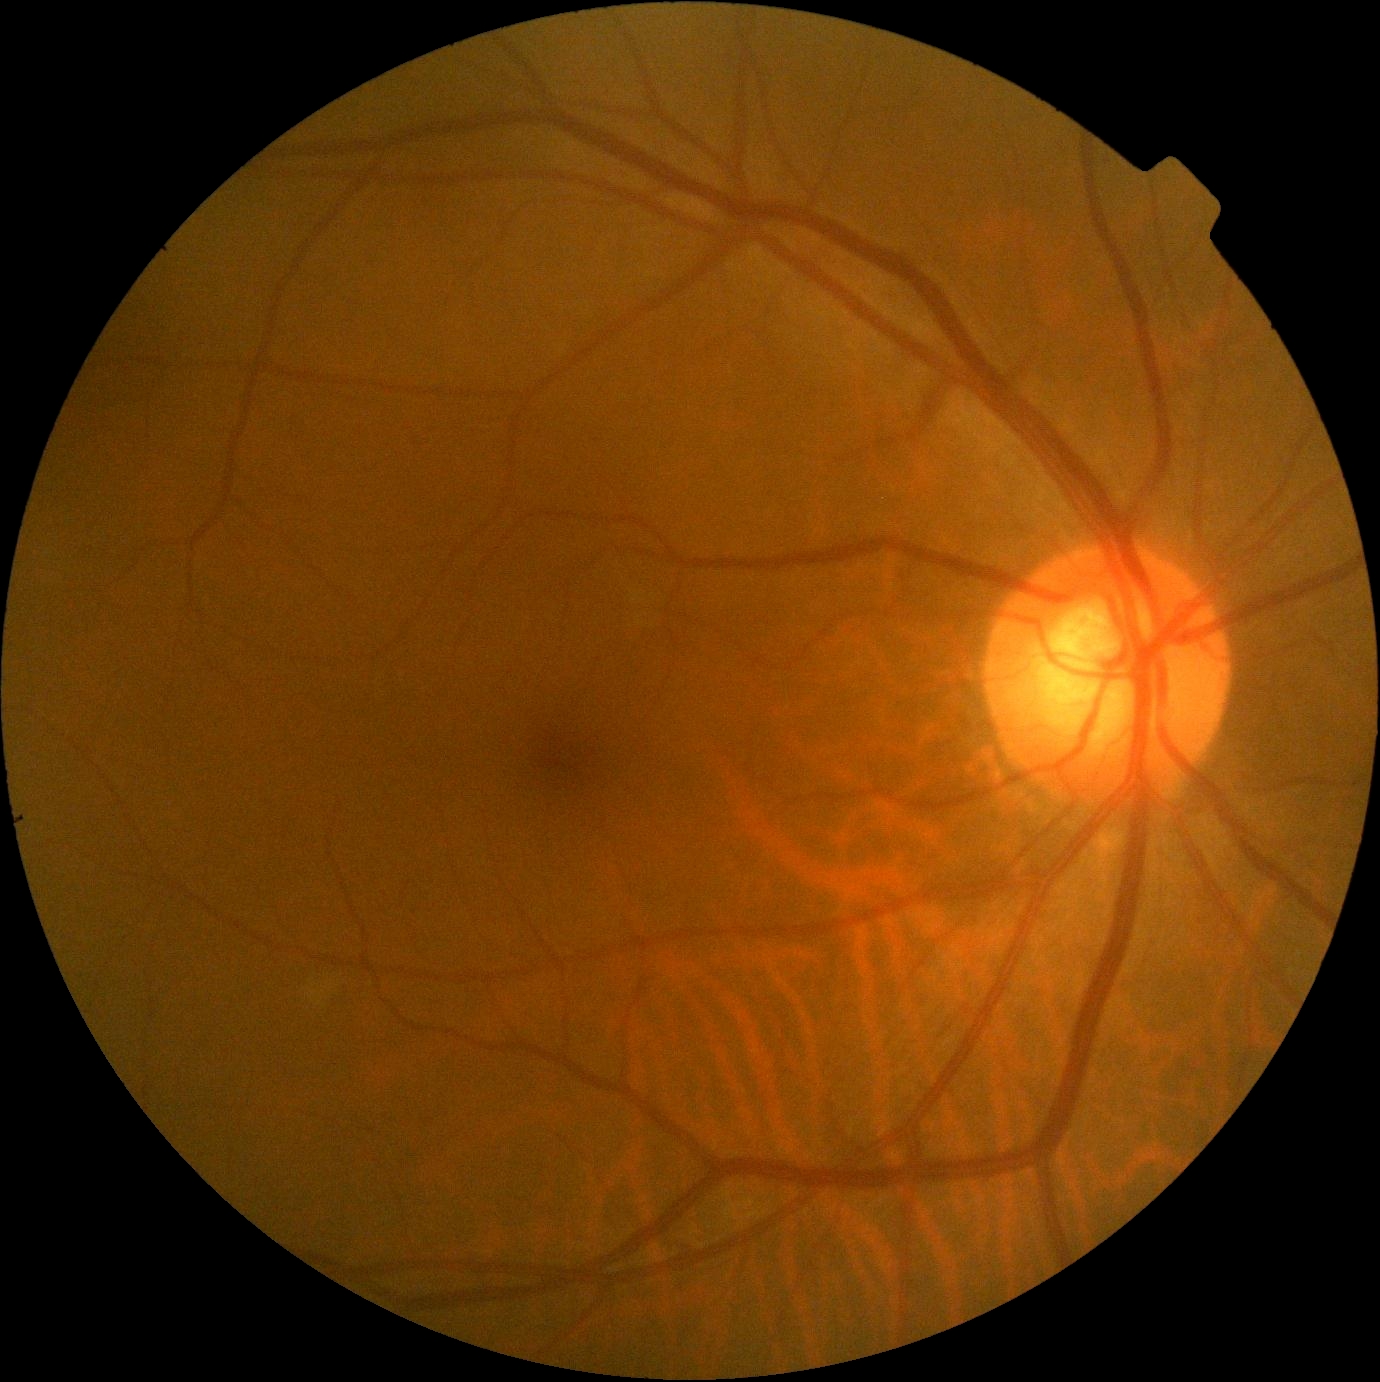

  dr_grade: 0/4
  dr_impression: no DR findings